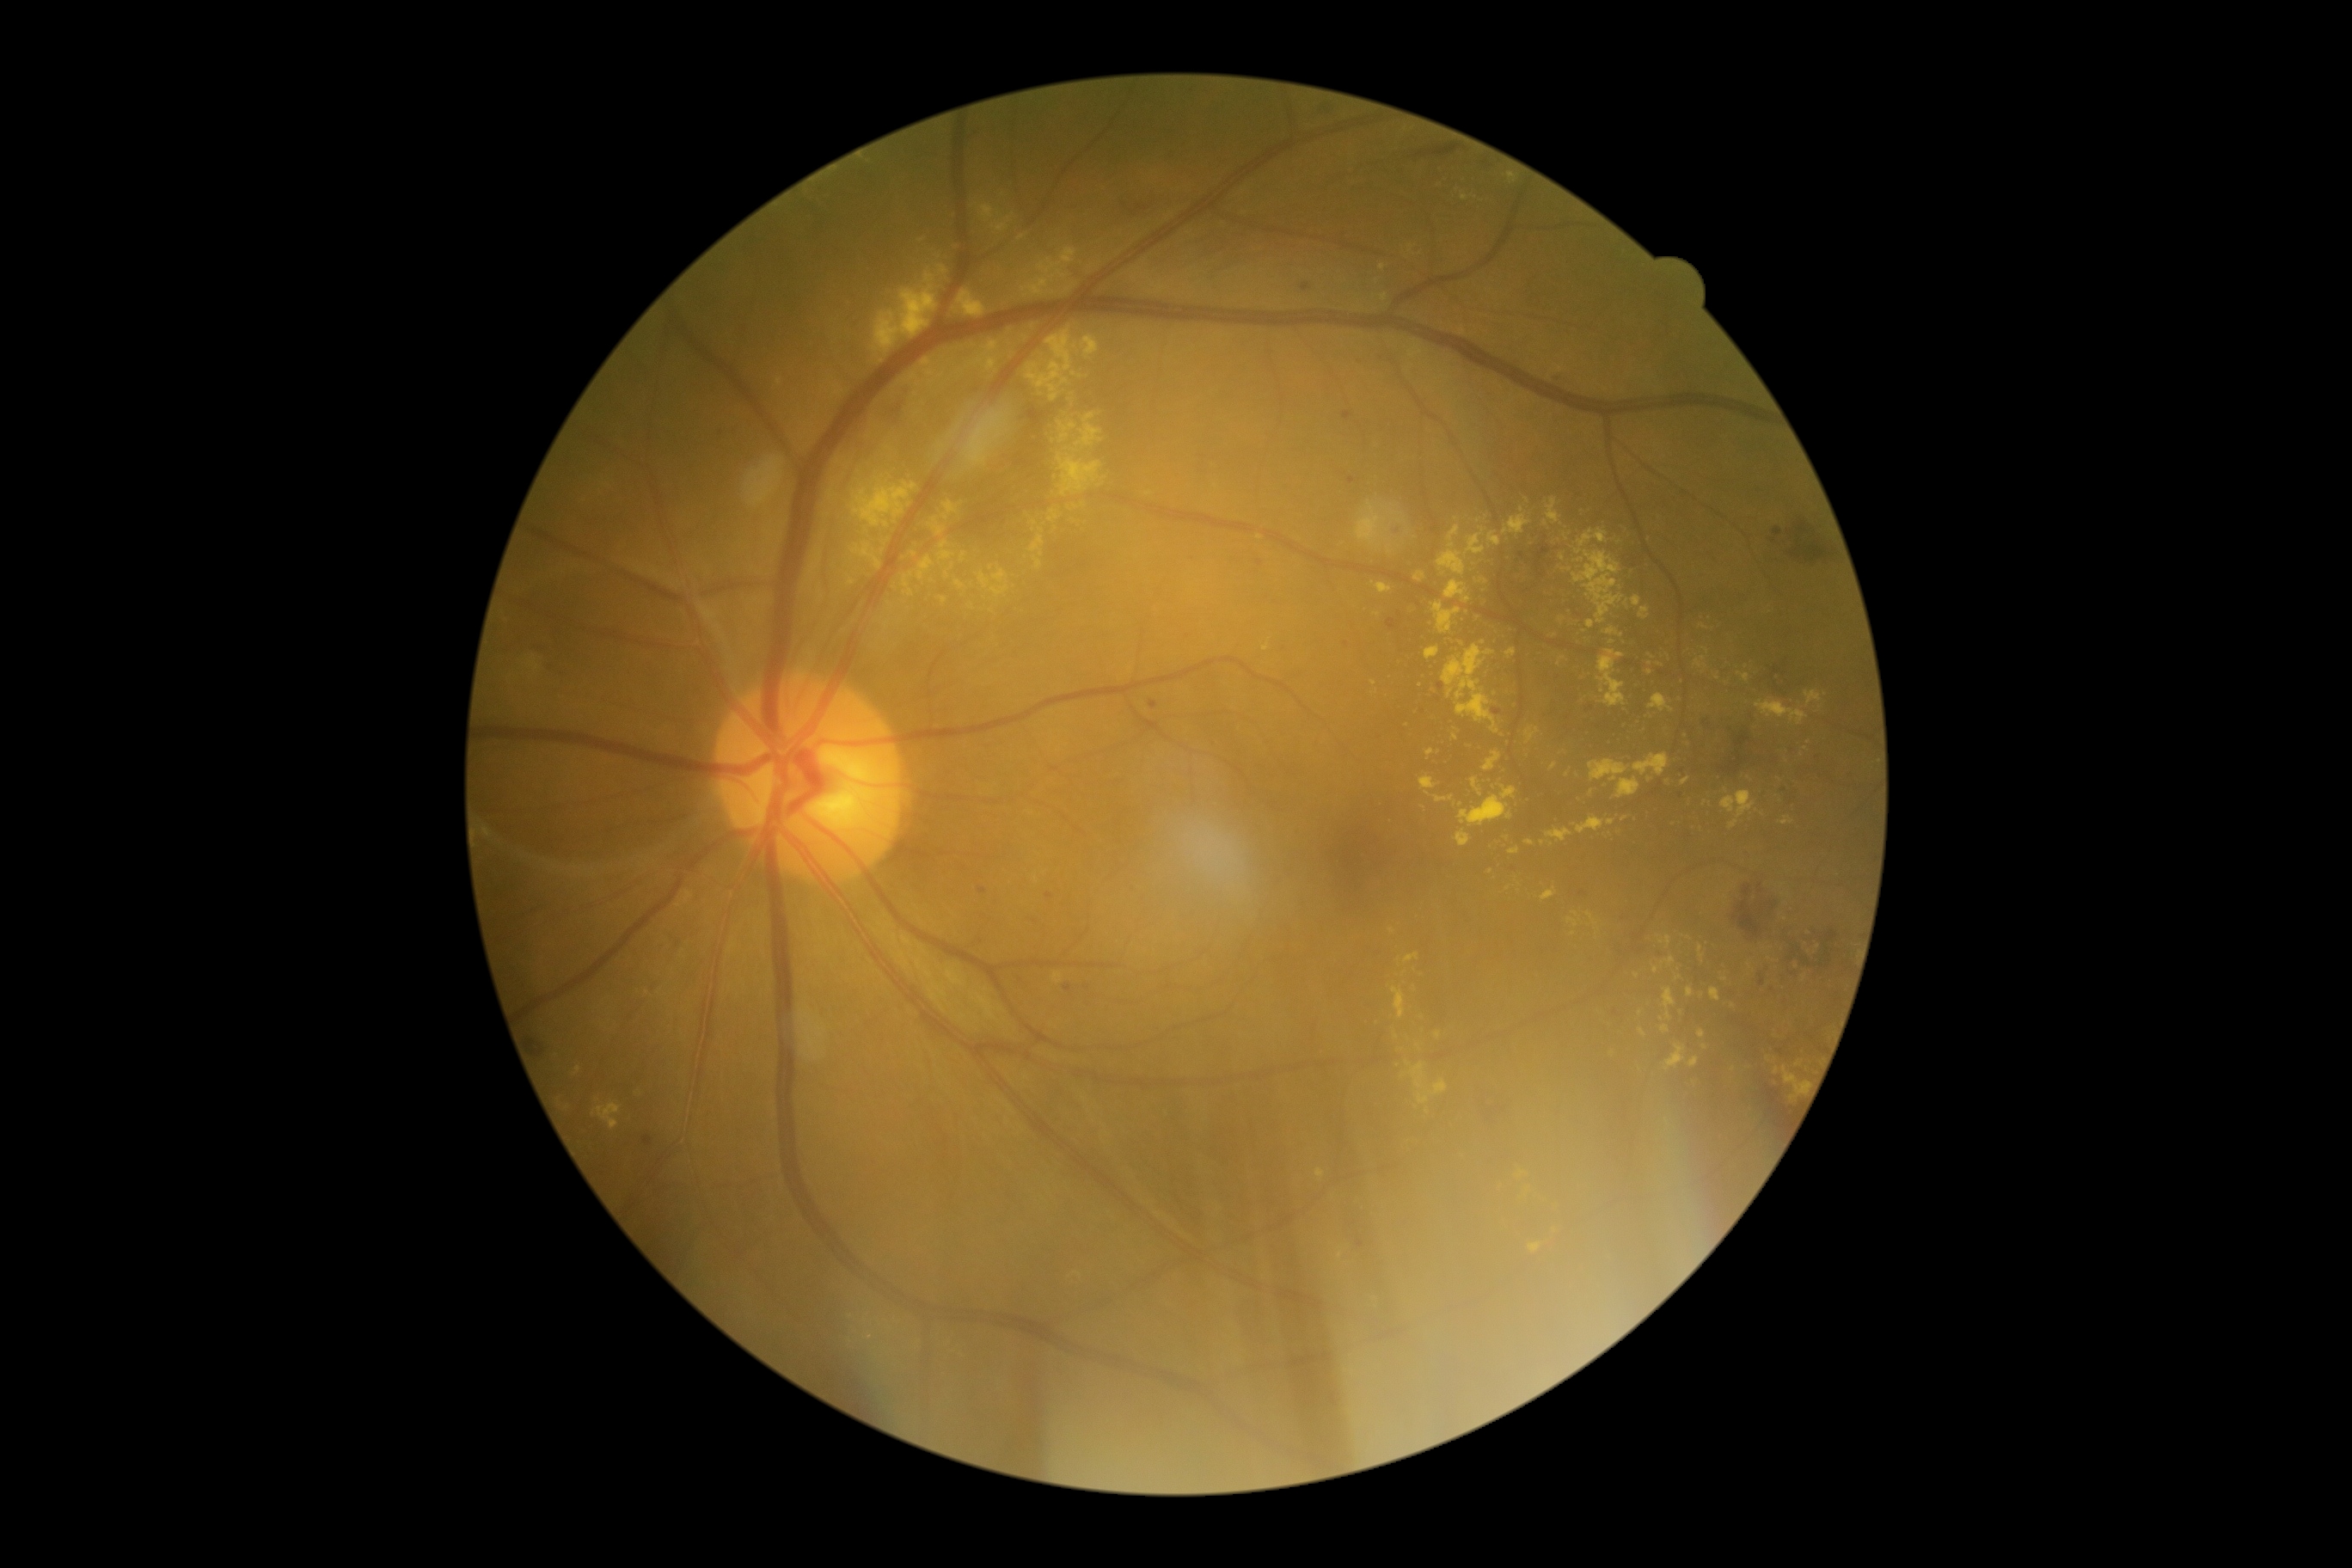 <lesions partial="true">
  <dr_grade>2</dr_grade>
  <ex partial="true">{"x1": 1663, "y1": 988, "x2": 1675, "y2": 1020}; {"x1": 1449, "y1": 689, "x2": 1454, "y2": 699}; {"x1": 1433, "y1": 603, "x2": 1462, "y2": 635}; {"x1": 1022, "y1": 247, "x2": 1077, "y2": 298}; {"x1": 1698, "y1": 945, "x2": 1705, "y2": 959}; {"x1": 1404, "y1": 953, "x2": 1419, "y2": 964}; {"x1": 898, "y1": 374, "x2": 919, "y2": 384}; {"x1": 1072, "y1": 372, "x2": 1082, "y2": 379}; {"x1": 805, "y1": 548, "x2": 823, "y2": 585}; {"x1": 1529, "y1": 1242, "x2": 1541, "y2": 1253}; {"x1": 1455, "y1": 830, "x2": 1471, "y2": 847}</ex>
  <ex_small_centers>x=1025, y=338; x=1701, y=1034; x=1758, y=810; x=1070, y=508; x=1750, y=966; x=1041, y=531; x=1575, y=914; x=1704, y=802; x=1479, y=522</ex_small_centers>
</lesions>